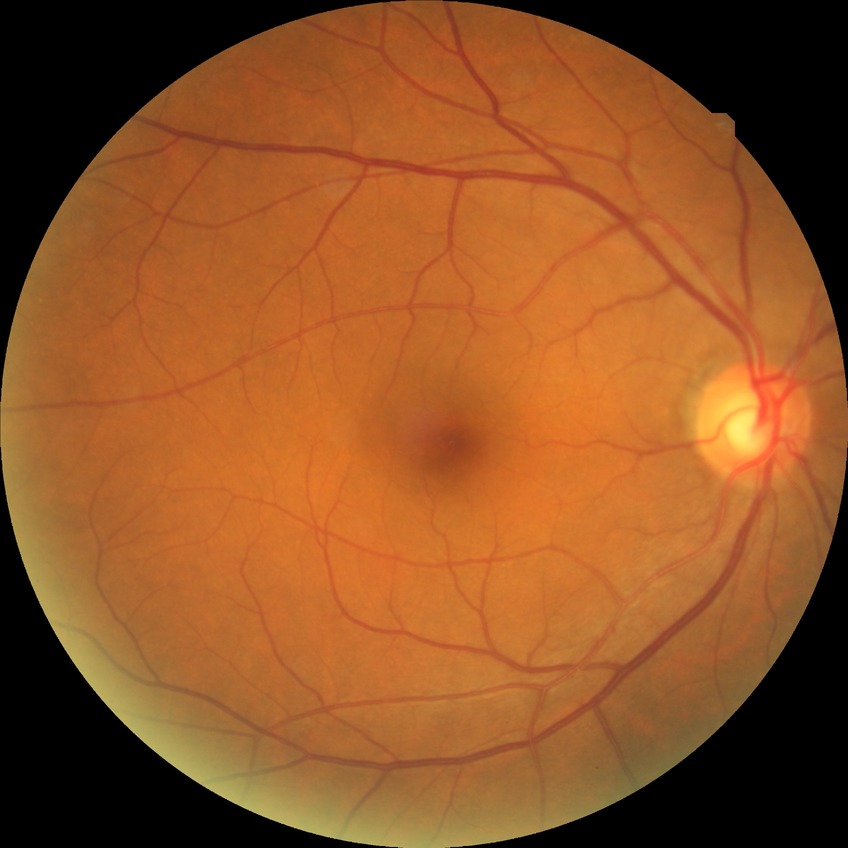
Diabetic retinopathy (DR) is no diabetic retinopathy (NDR).